Retinal fundus photograph — 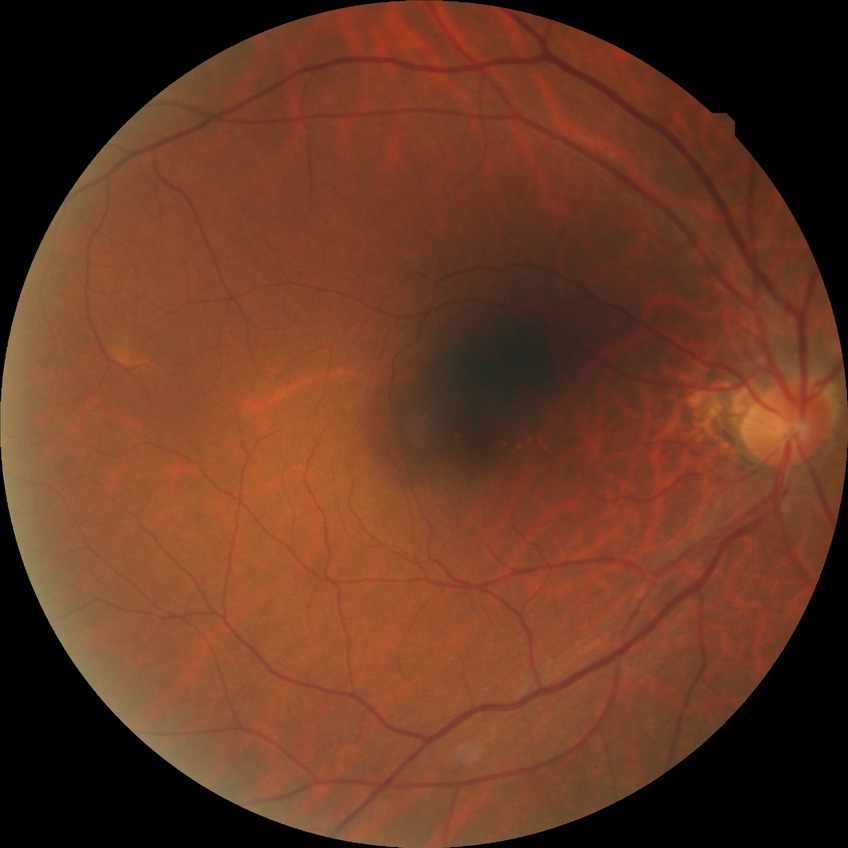
DR severity = NDR